1240x1240px · pediatric wide-field fundus photograph.
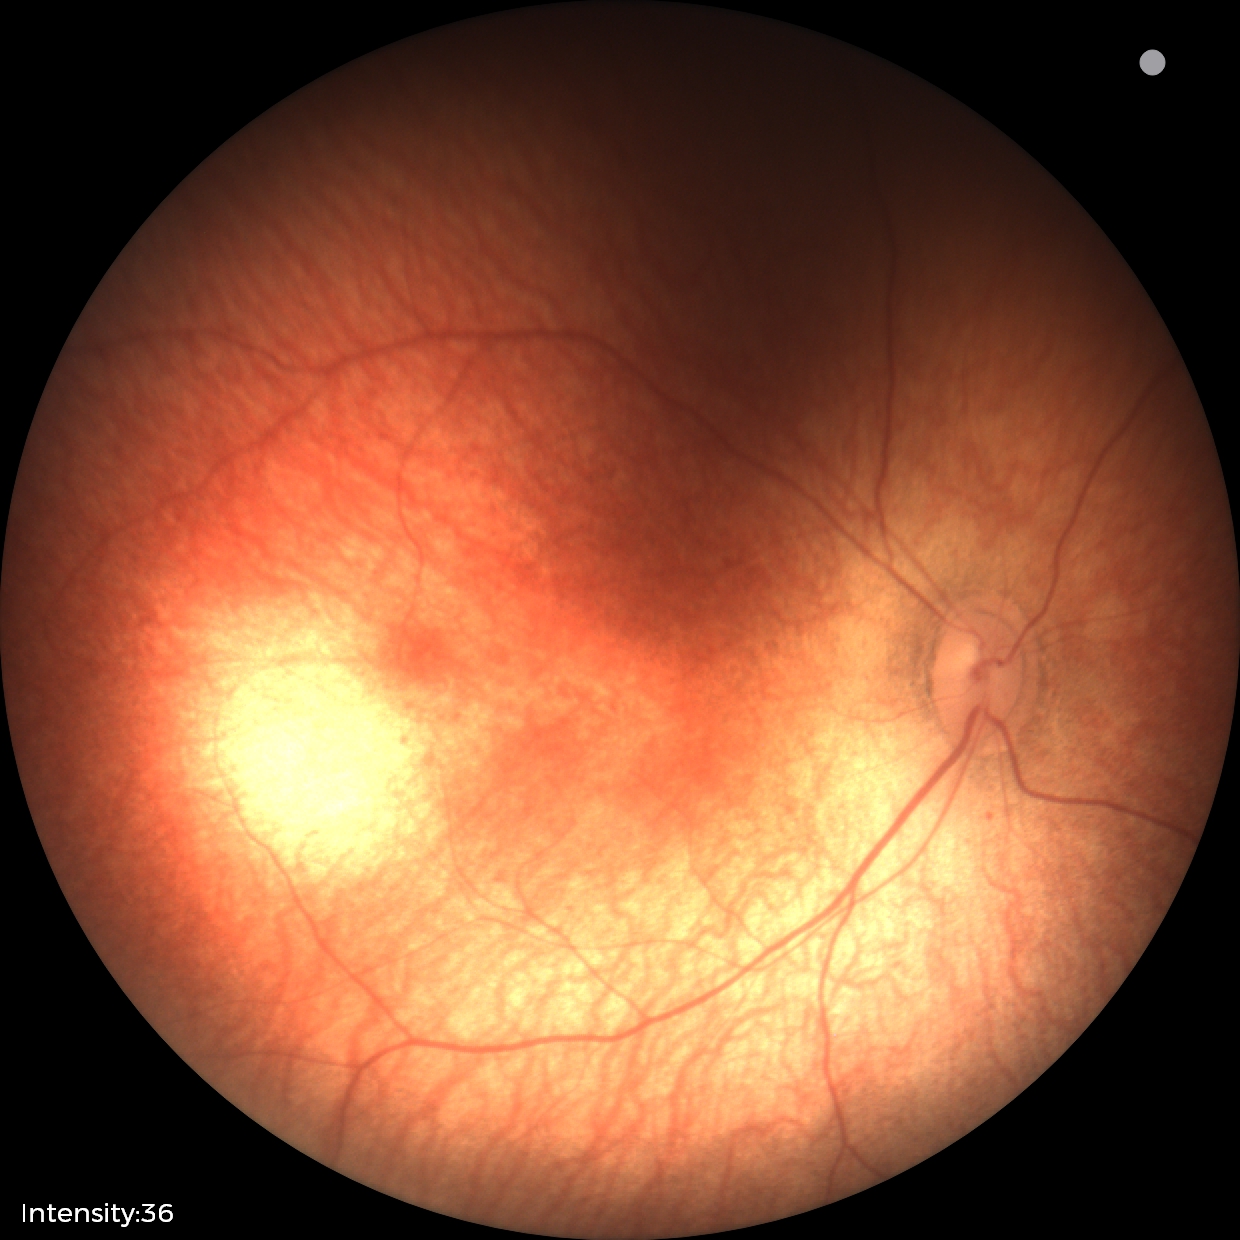

Screening diagnosis: no abnormal retinal findings.